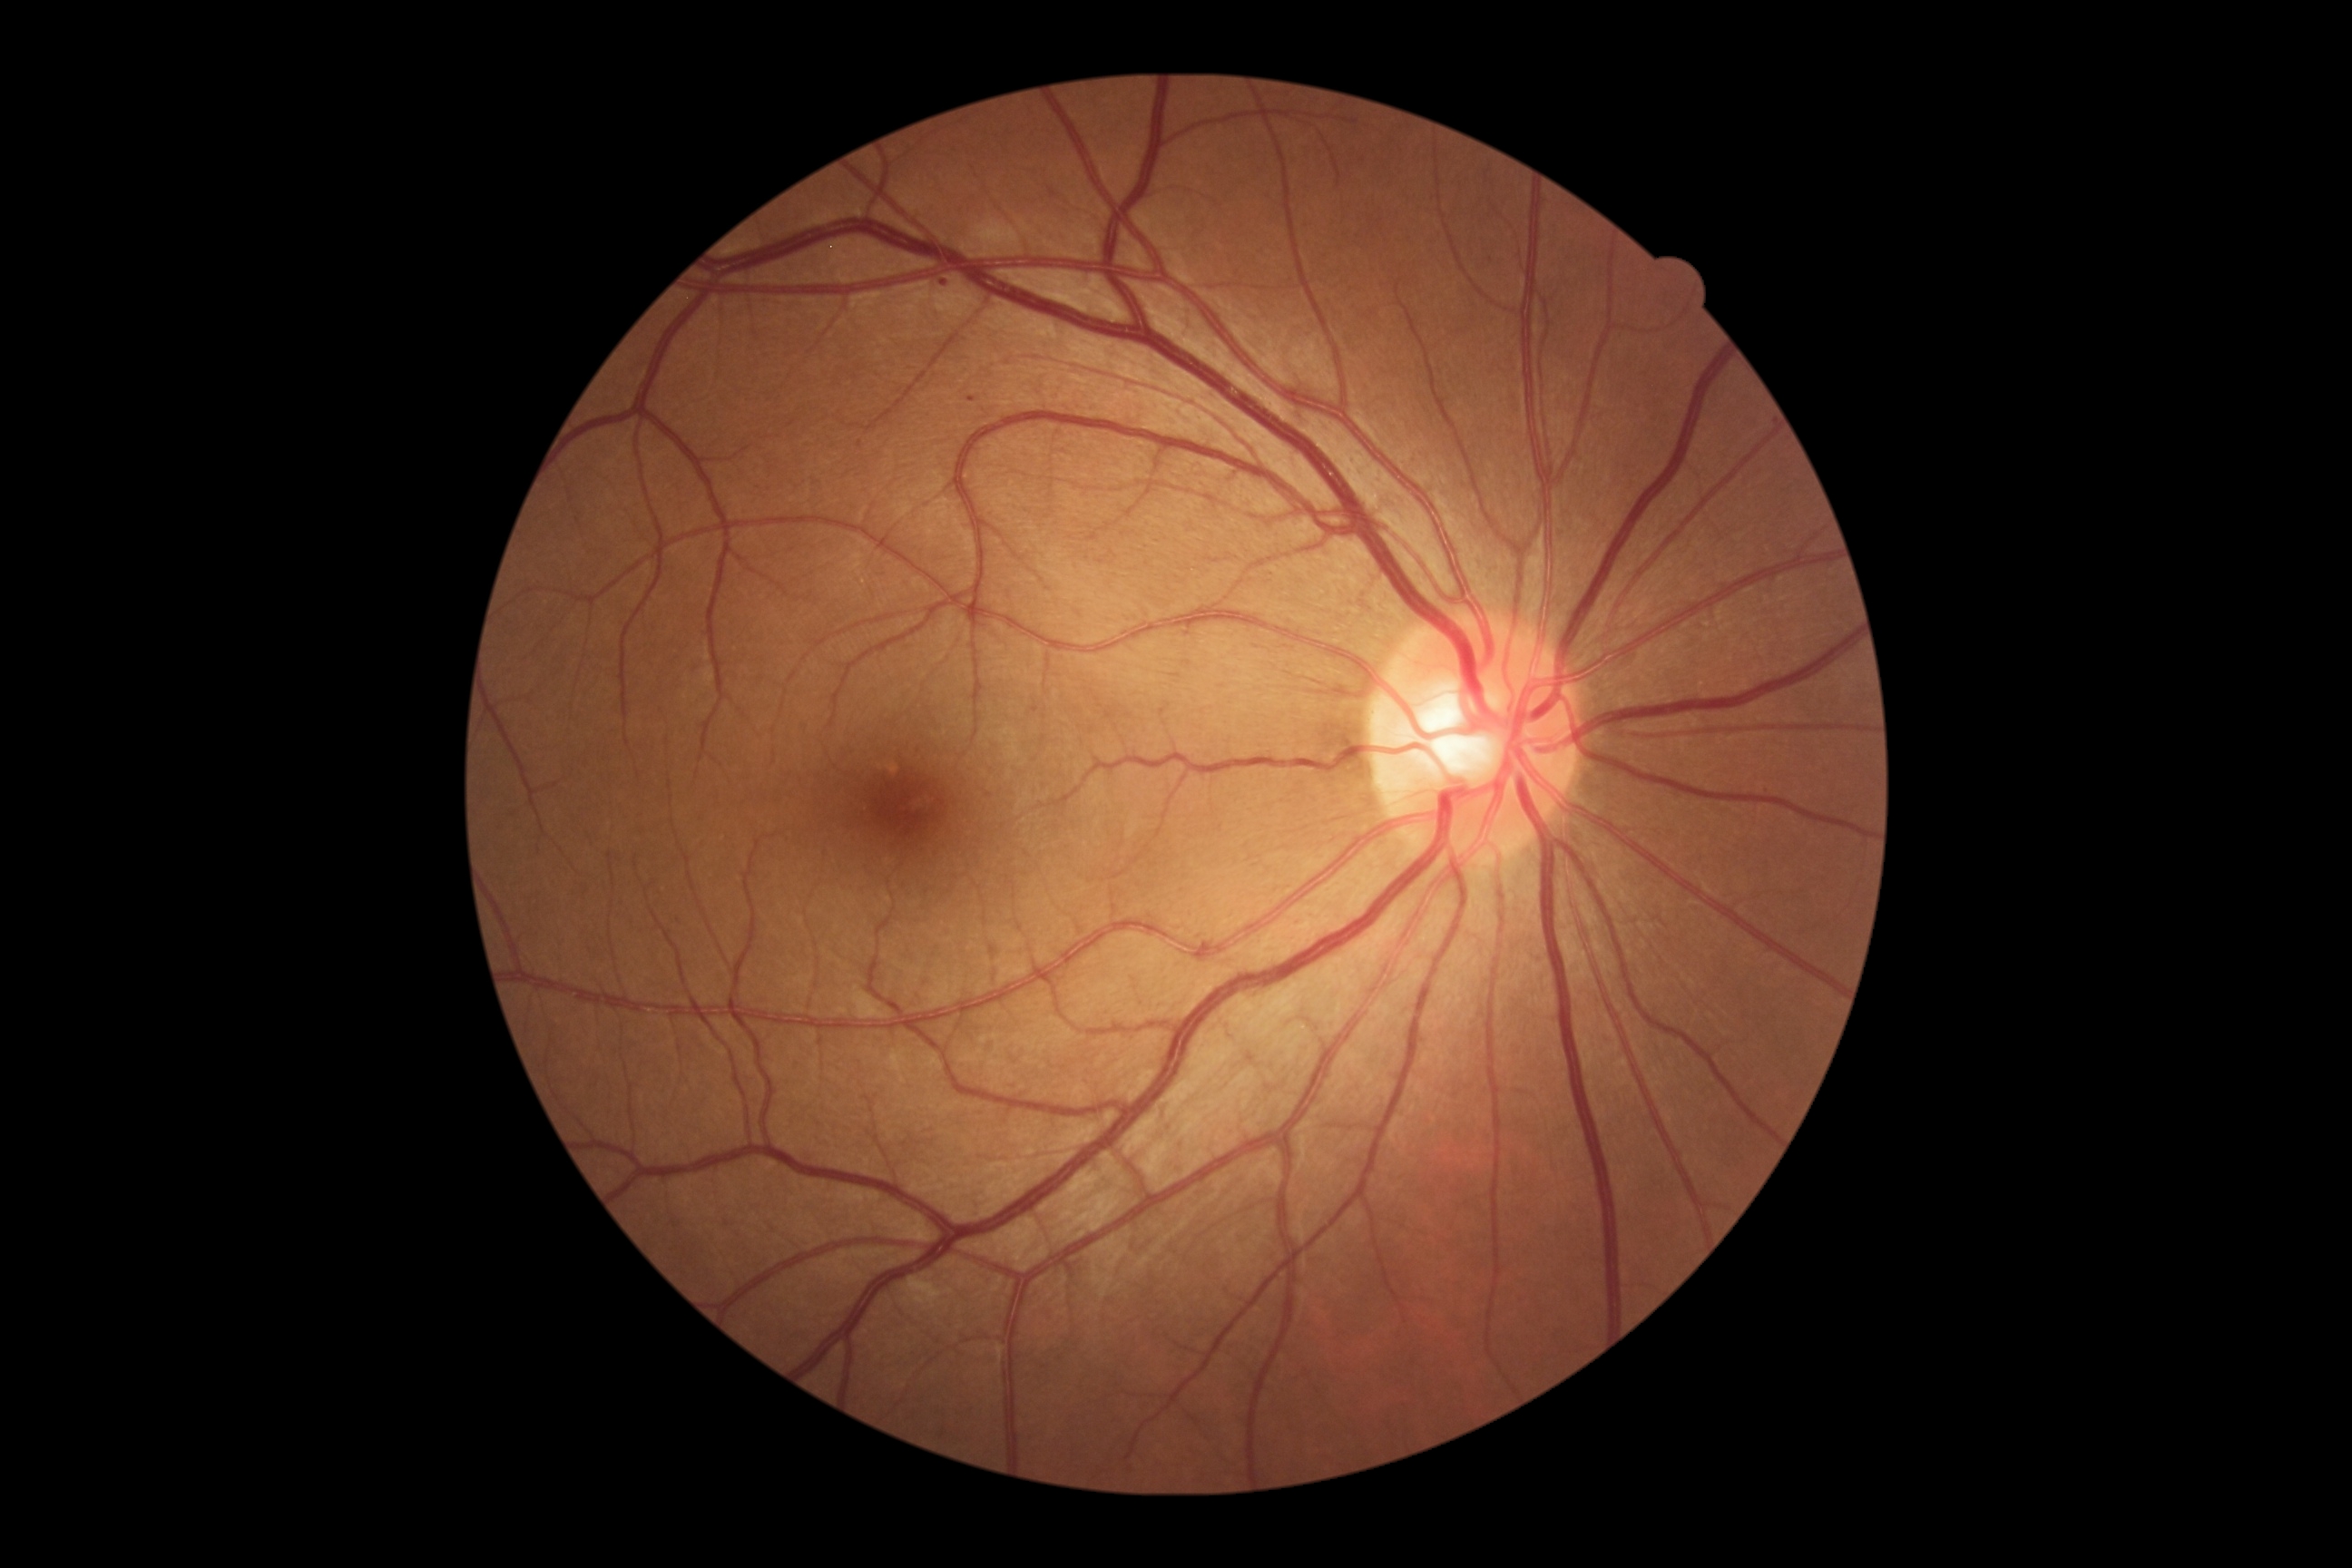

DR stage: grade 1.